Pediatric retinal photograph (wide-field).
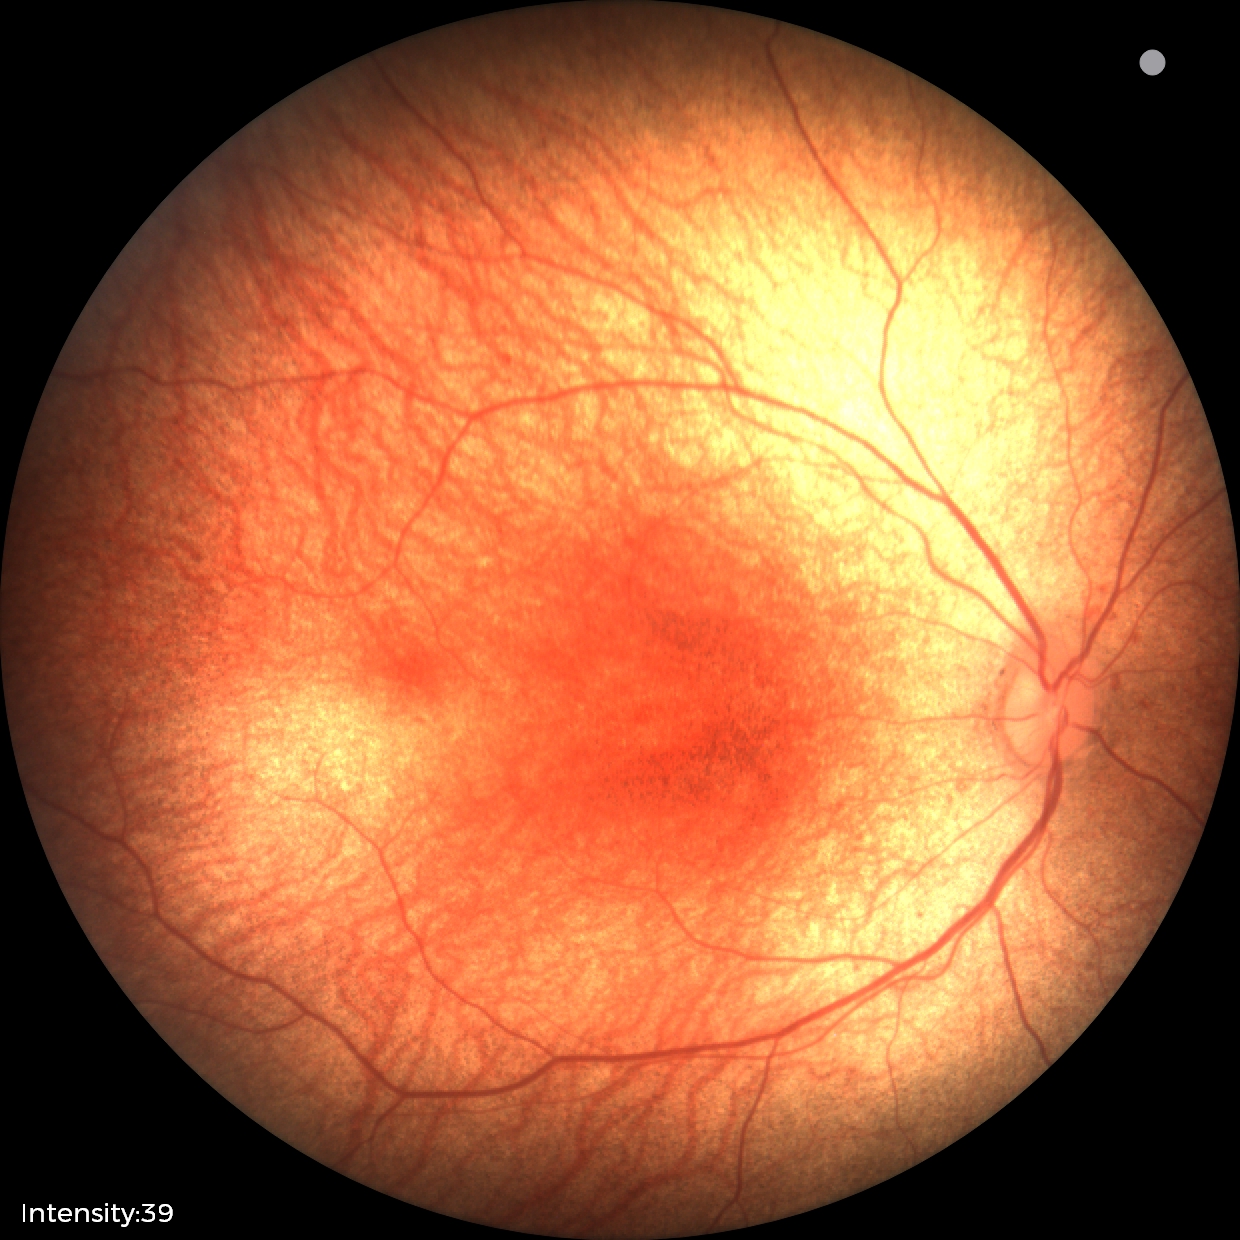 Screening diagnosis = no abnormalities.